Retinal fundus photograph: 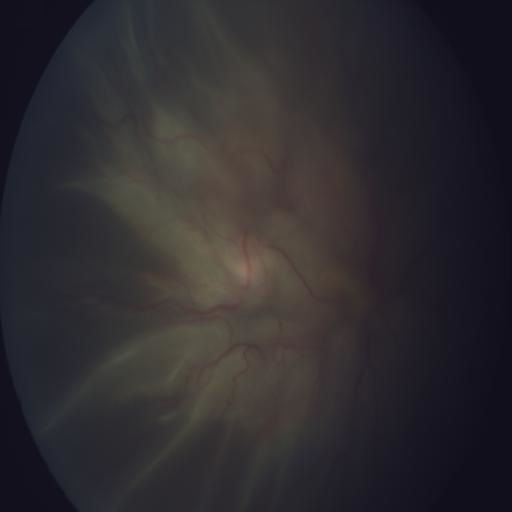 Showing retinal traction (RT) & retinal detachment (RD).